45-degree field of view. Image size 2144x1424 — 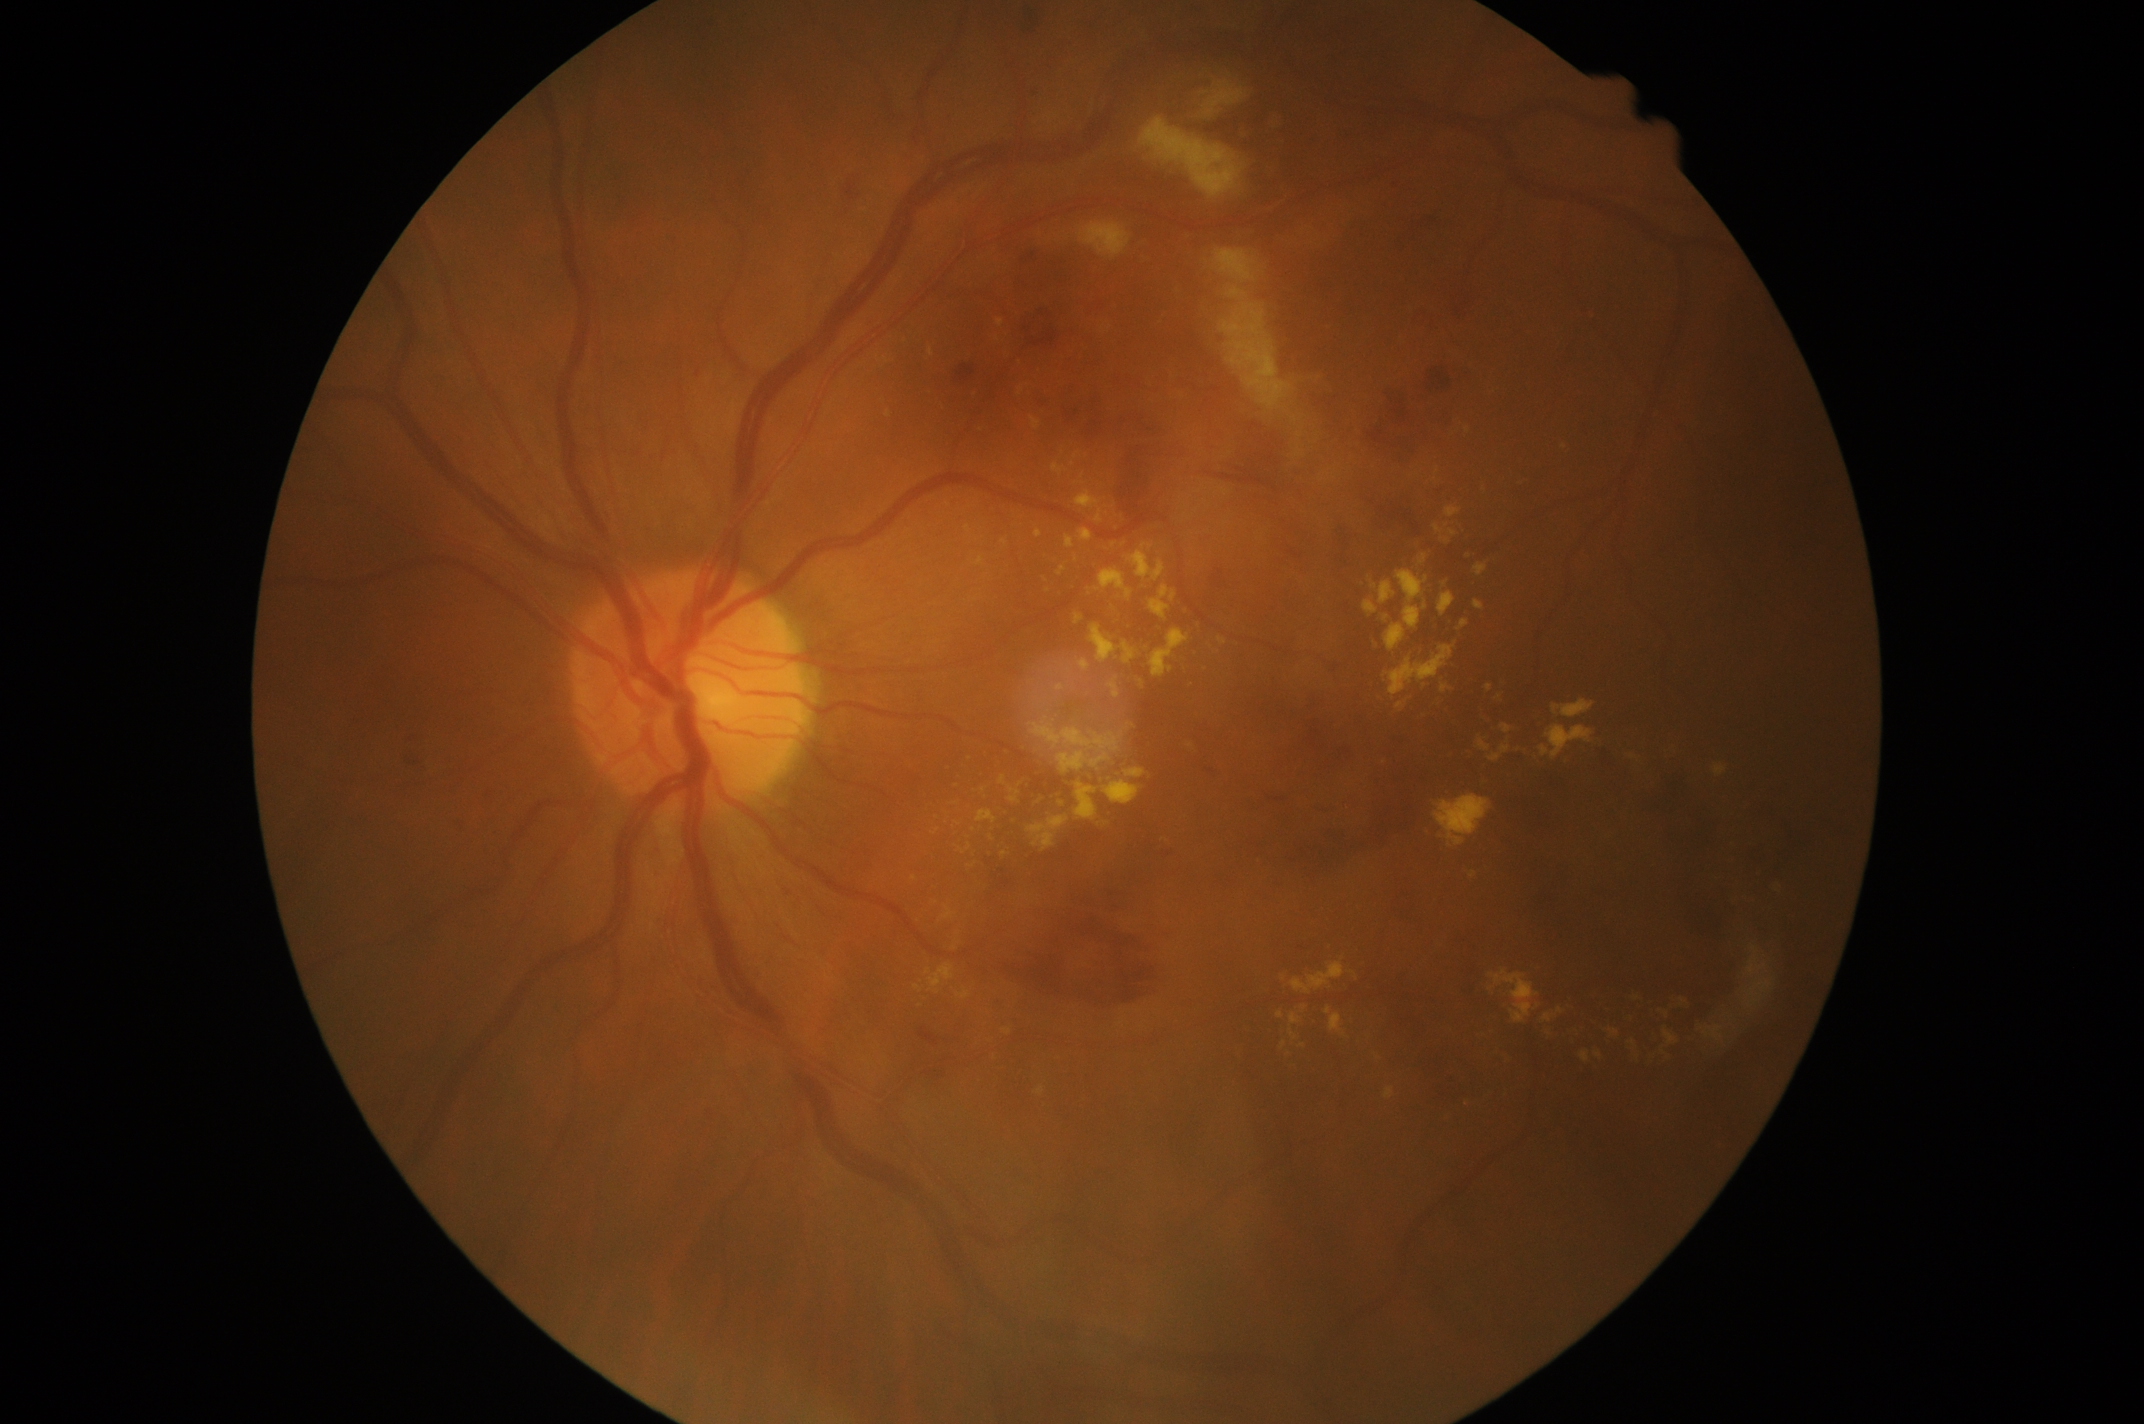

diabetic retinopathy = 2 — more than just microaneurysms but less than severe NPDR.